1924x1556, 200-degree field of view, wide-field retinal mosaic image — 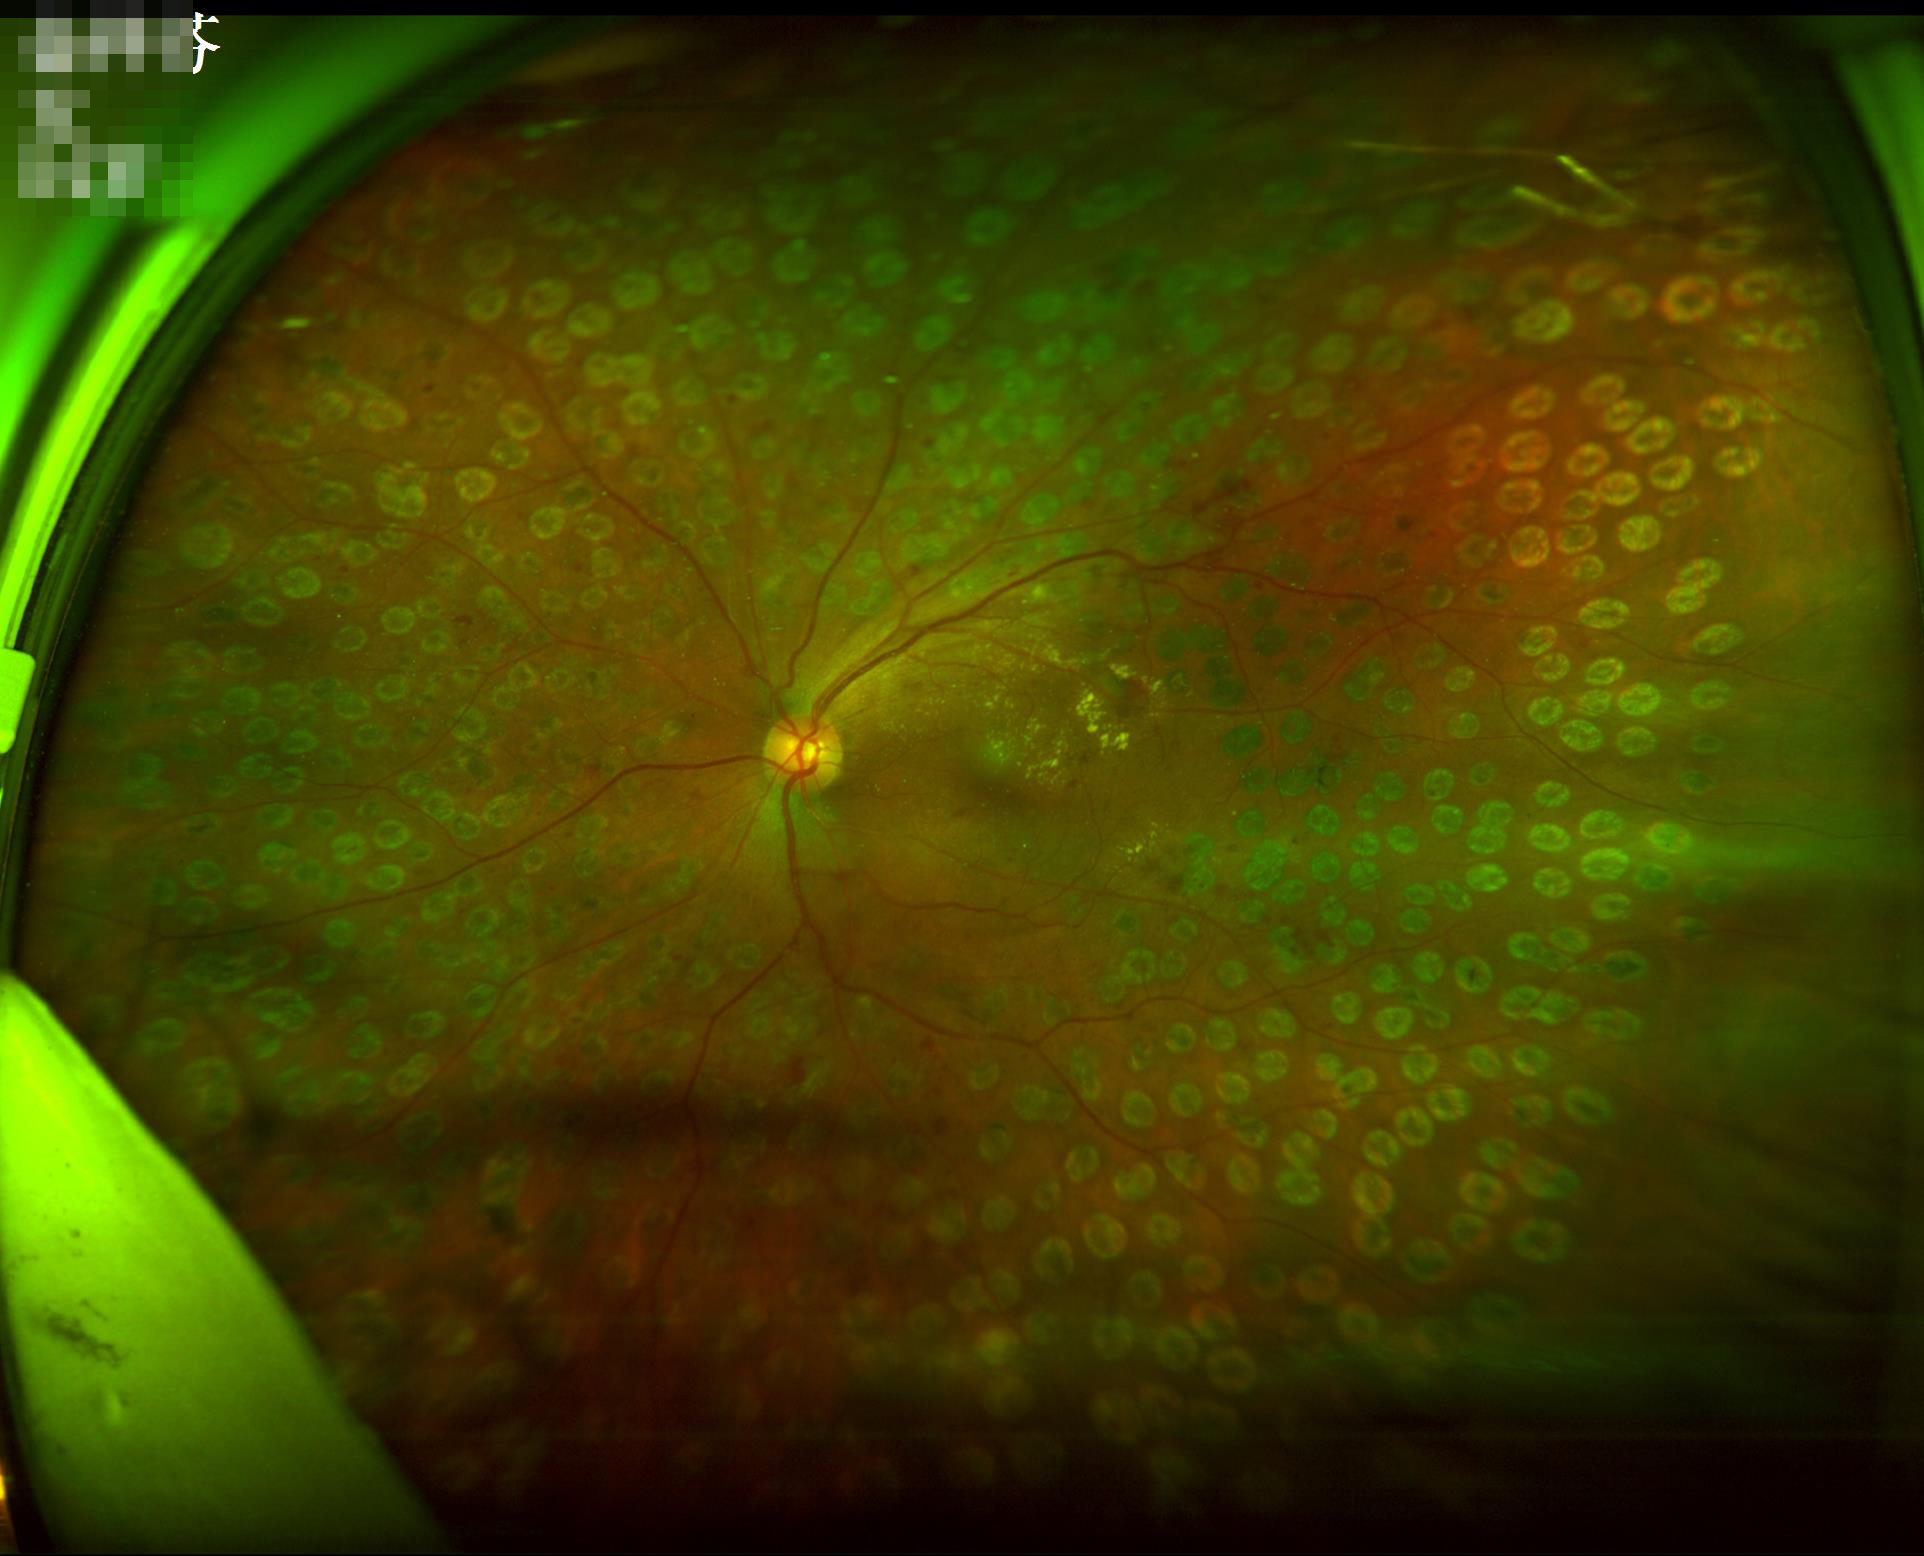 Overall quality is good and the image is gradable. Vessels and details are readily distinguishable. Illumination is even. Image is sharp throughout the field.